Wide-field fundus photograph of an infant:
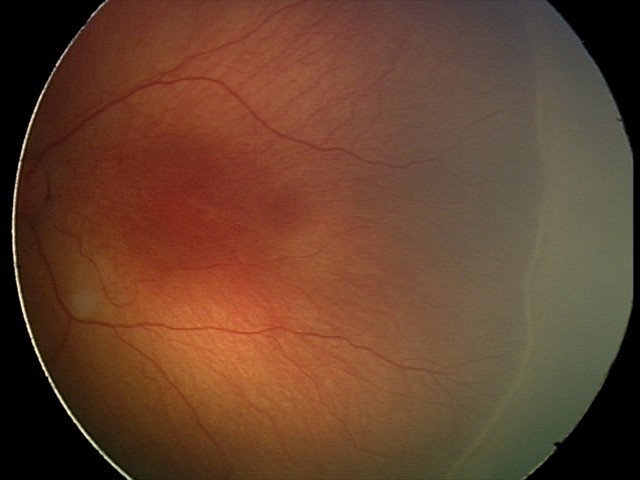

Plus disease absent.
Diagnosis from this screening exam: retinopathy of prematurity stage 2.